NIDEK AFC-230 fundus camera; image size 848x848:
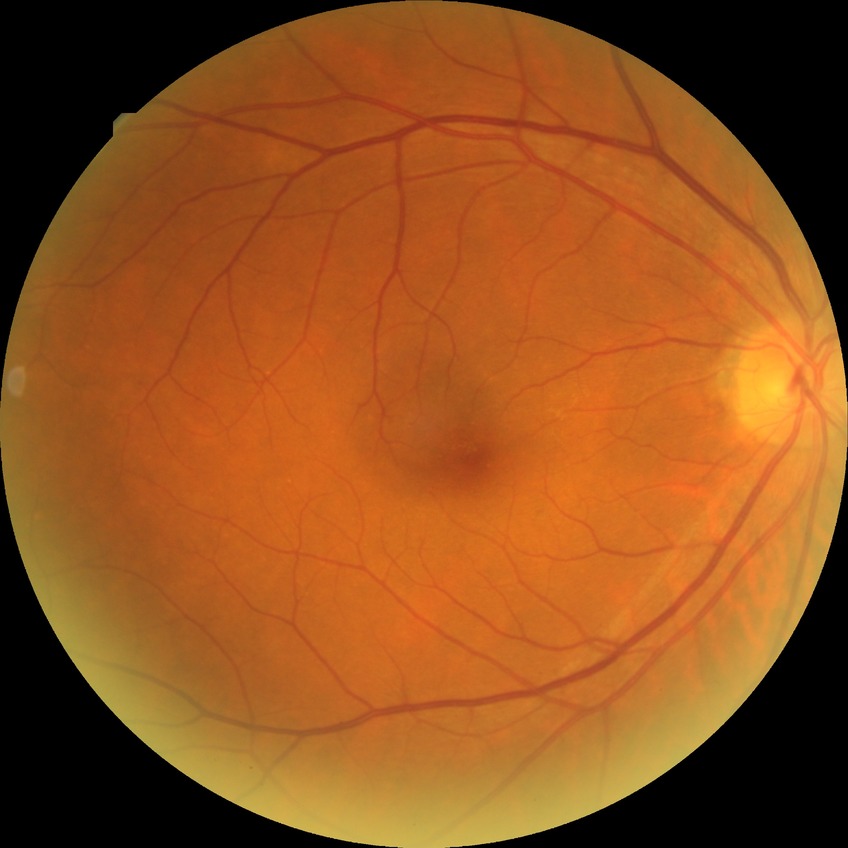 Diabetic retinopathy (DR) is NDR (no diabetic retinopathy).